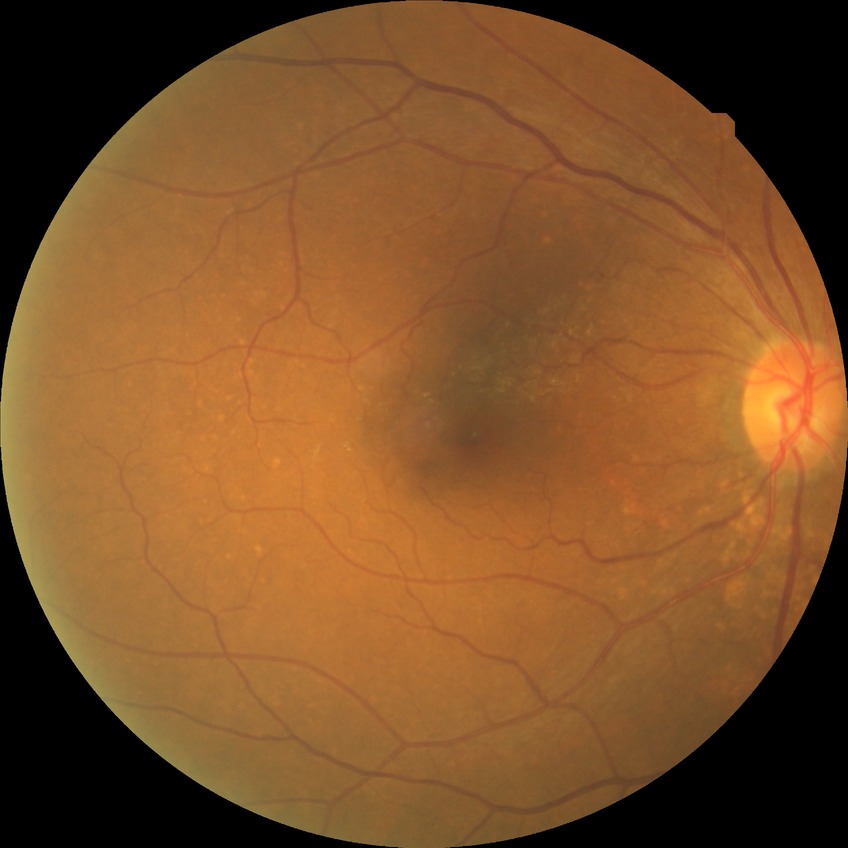

Modified Davis grading: no diabetic retinopathy.